45° field of view, 2352 x 1568 pixels, CFP
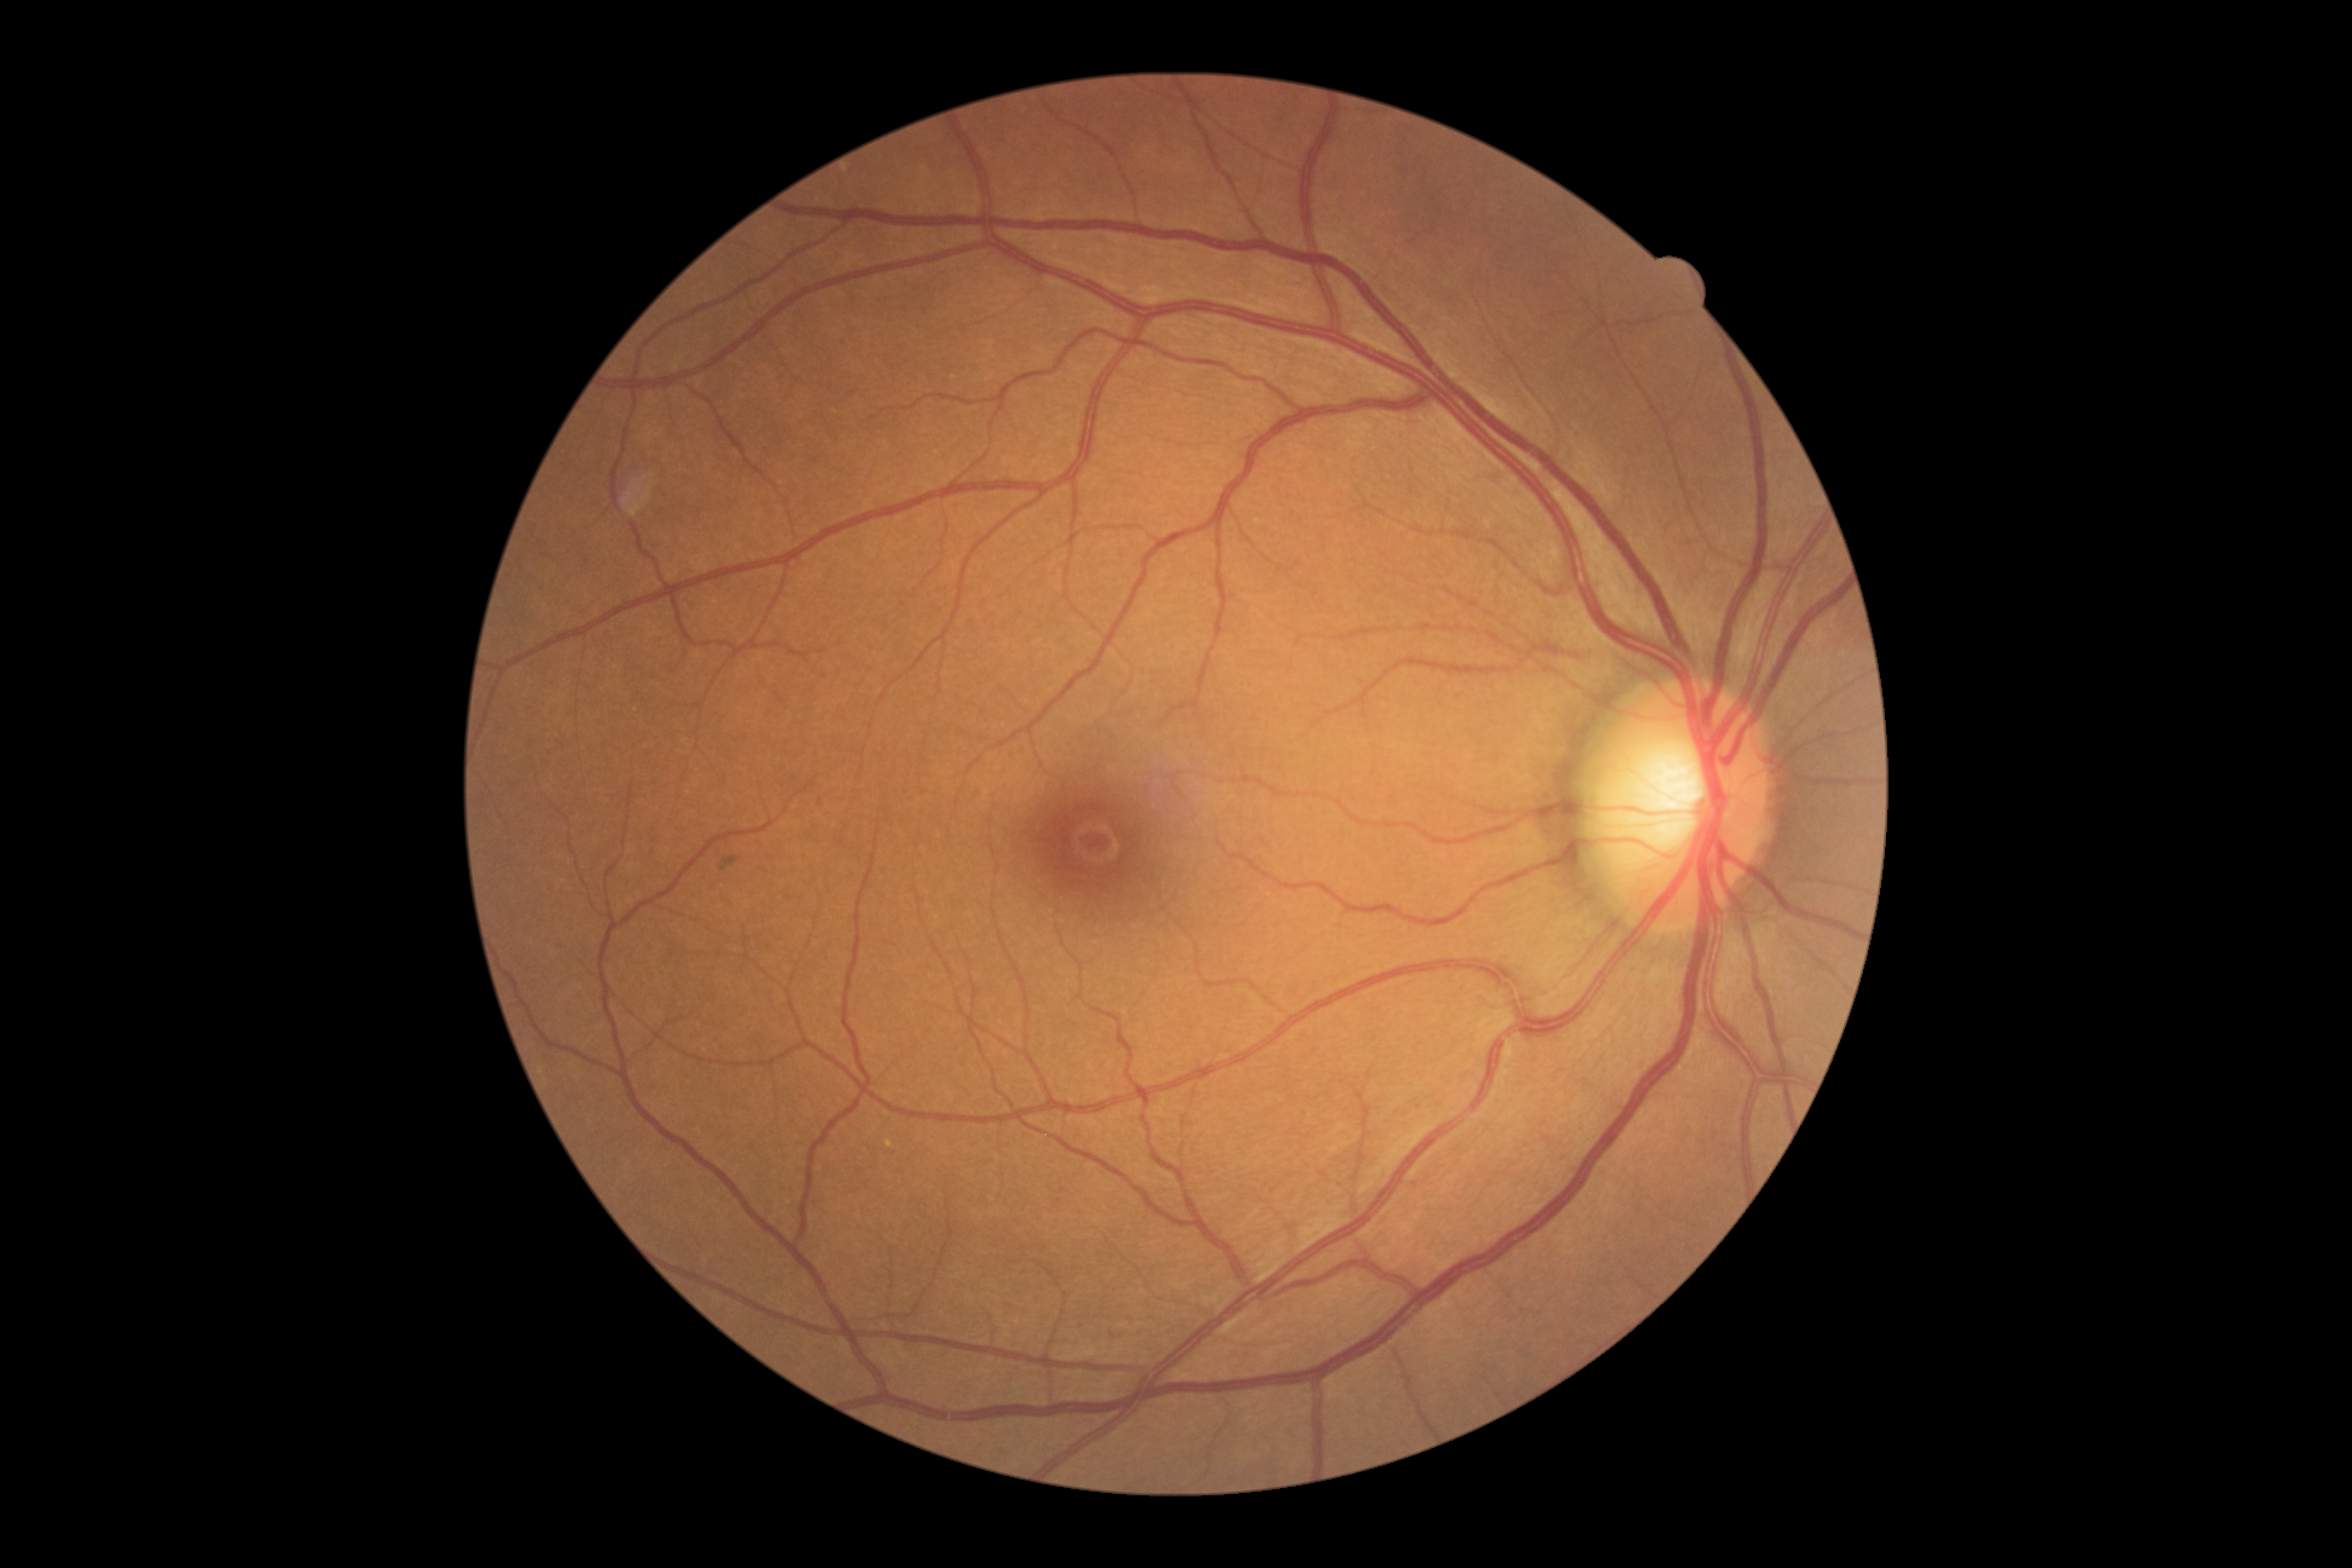
{"dr_impression": "no DR findings", "dr_grade": "0/4"}